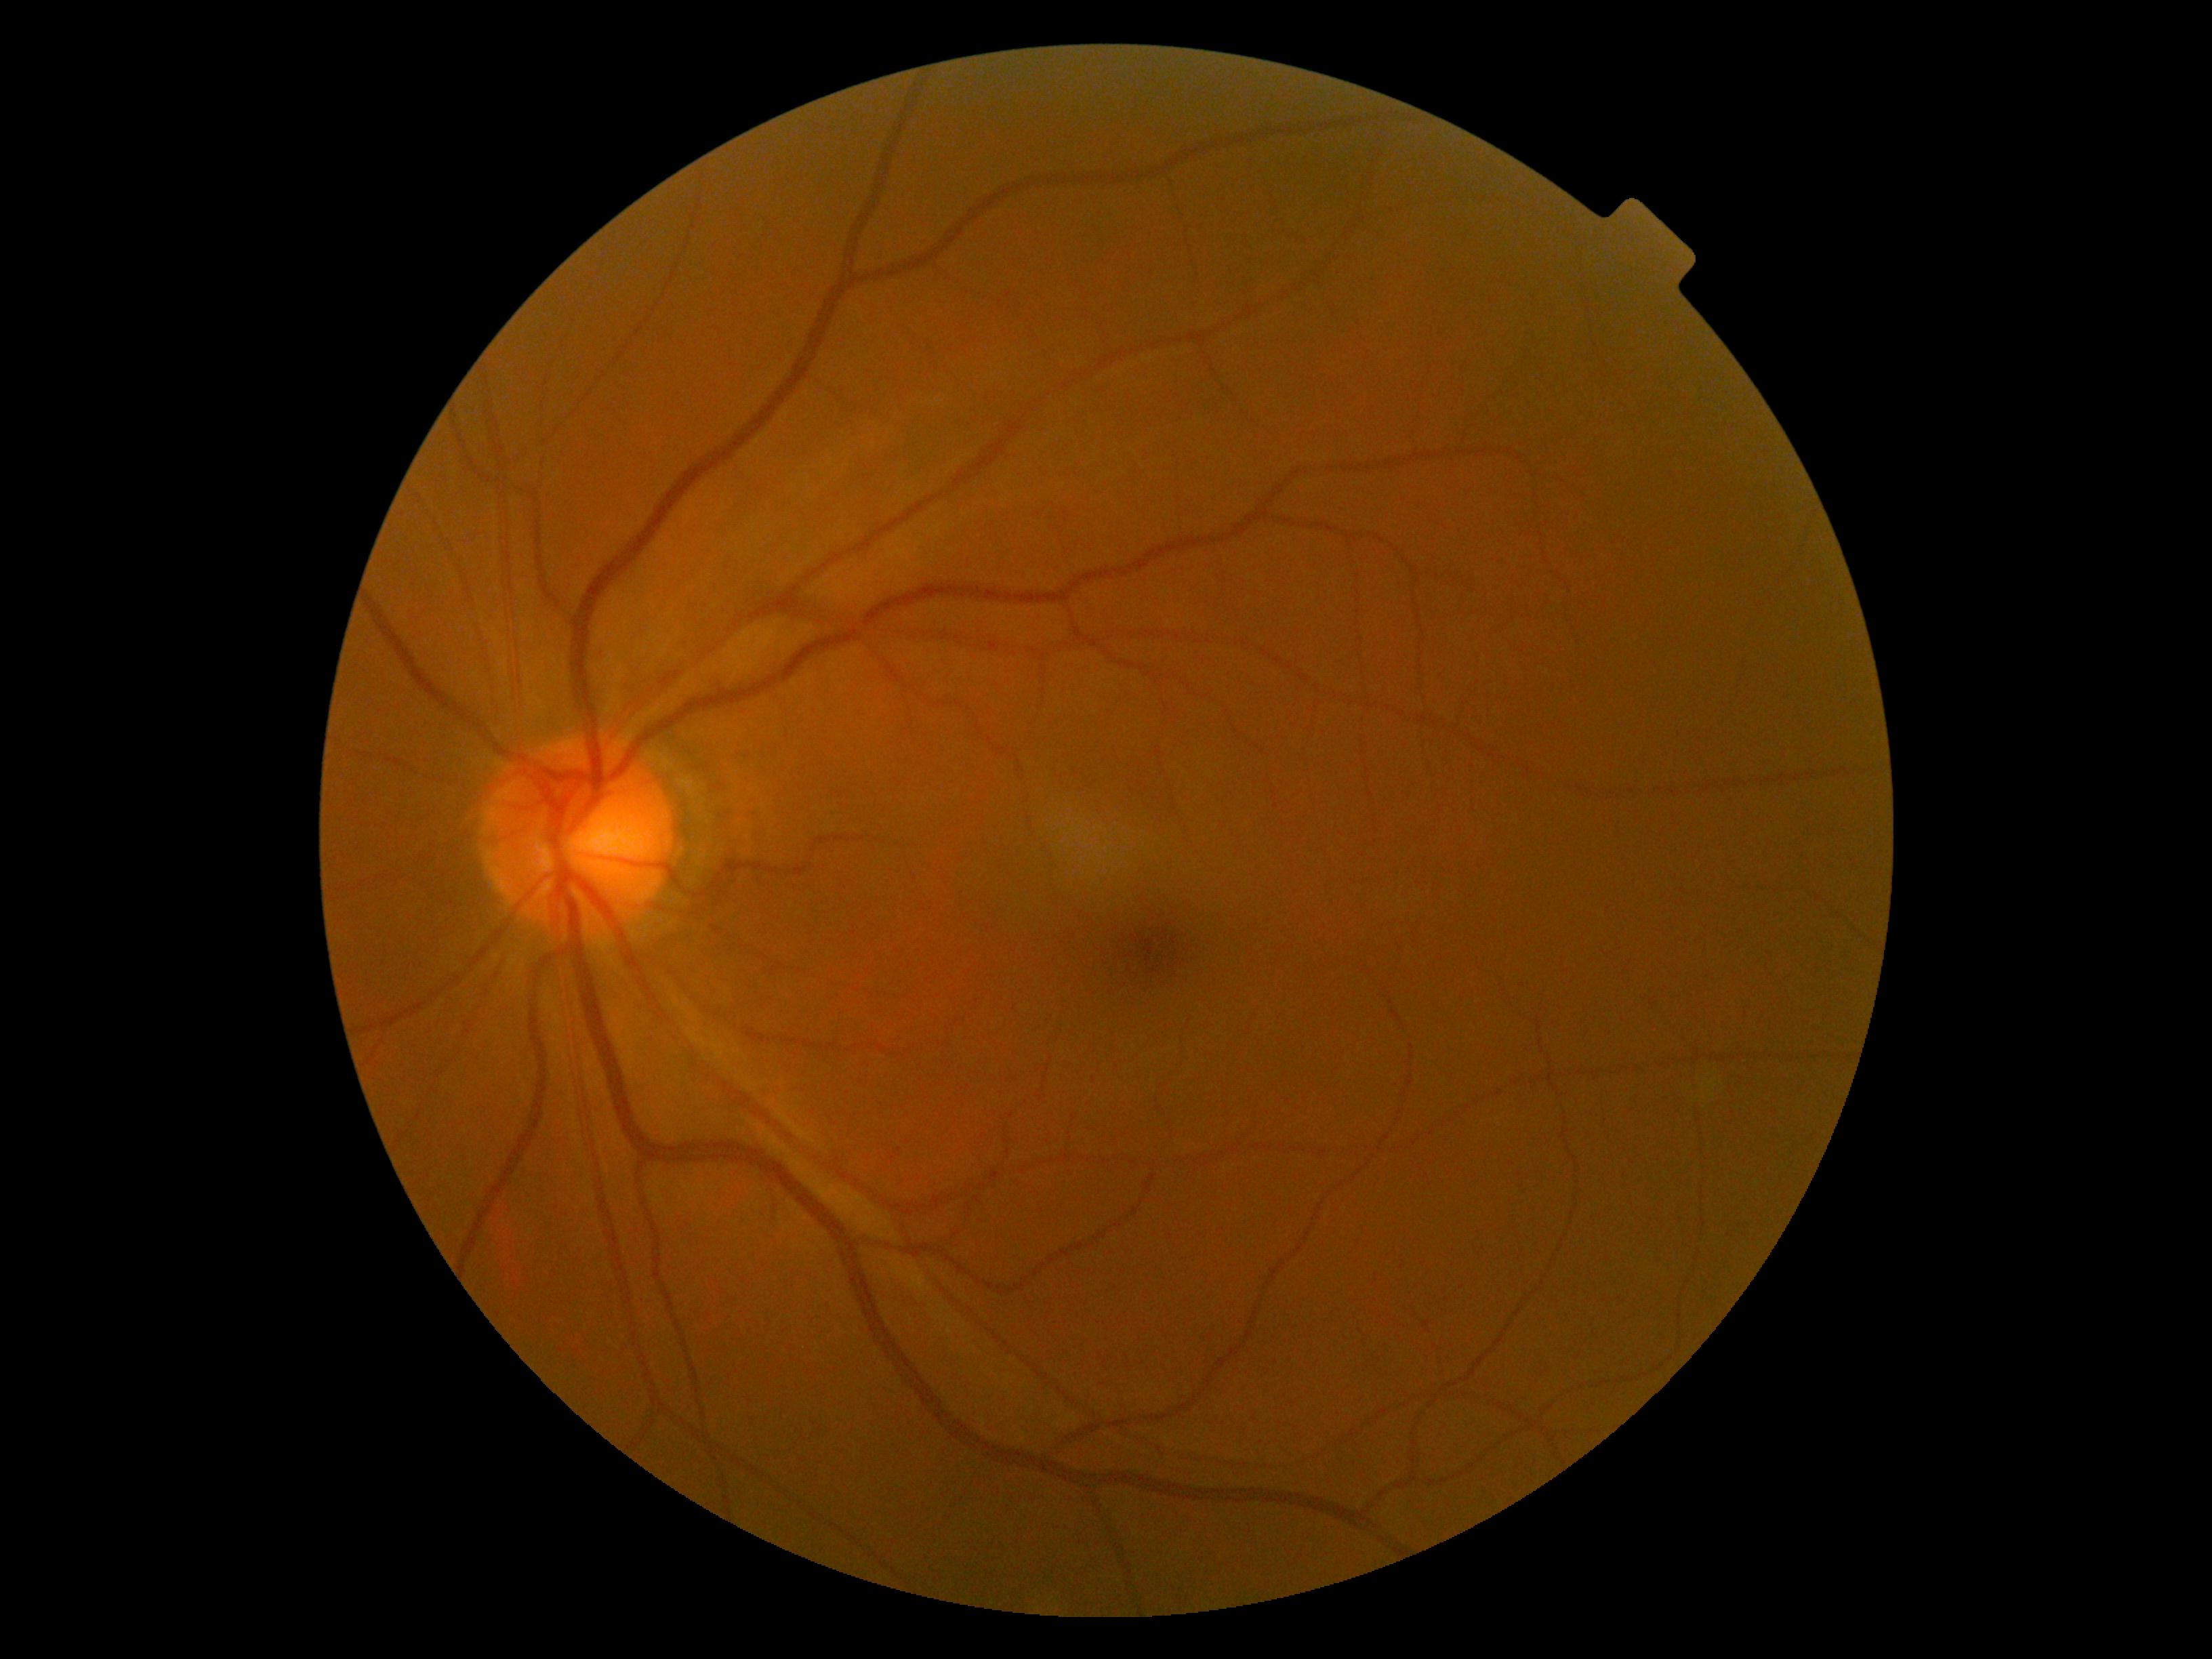
DR grade: 0 (no apparent retinopathy).